1659 by 2212 pixels
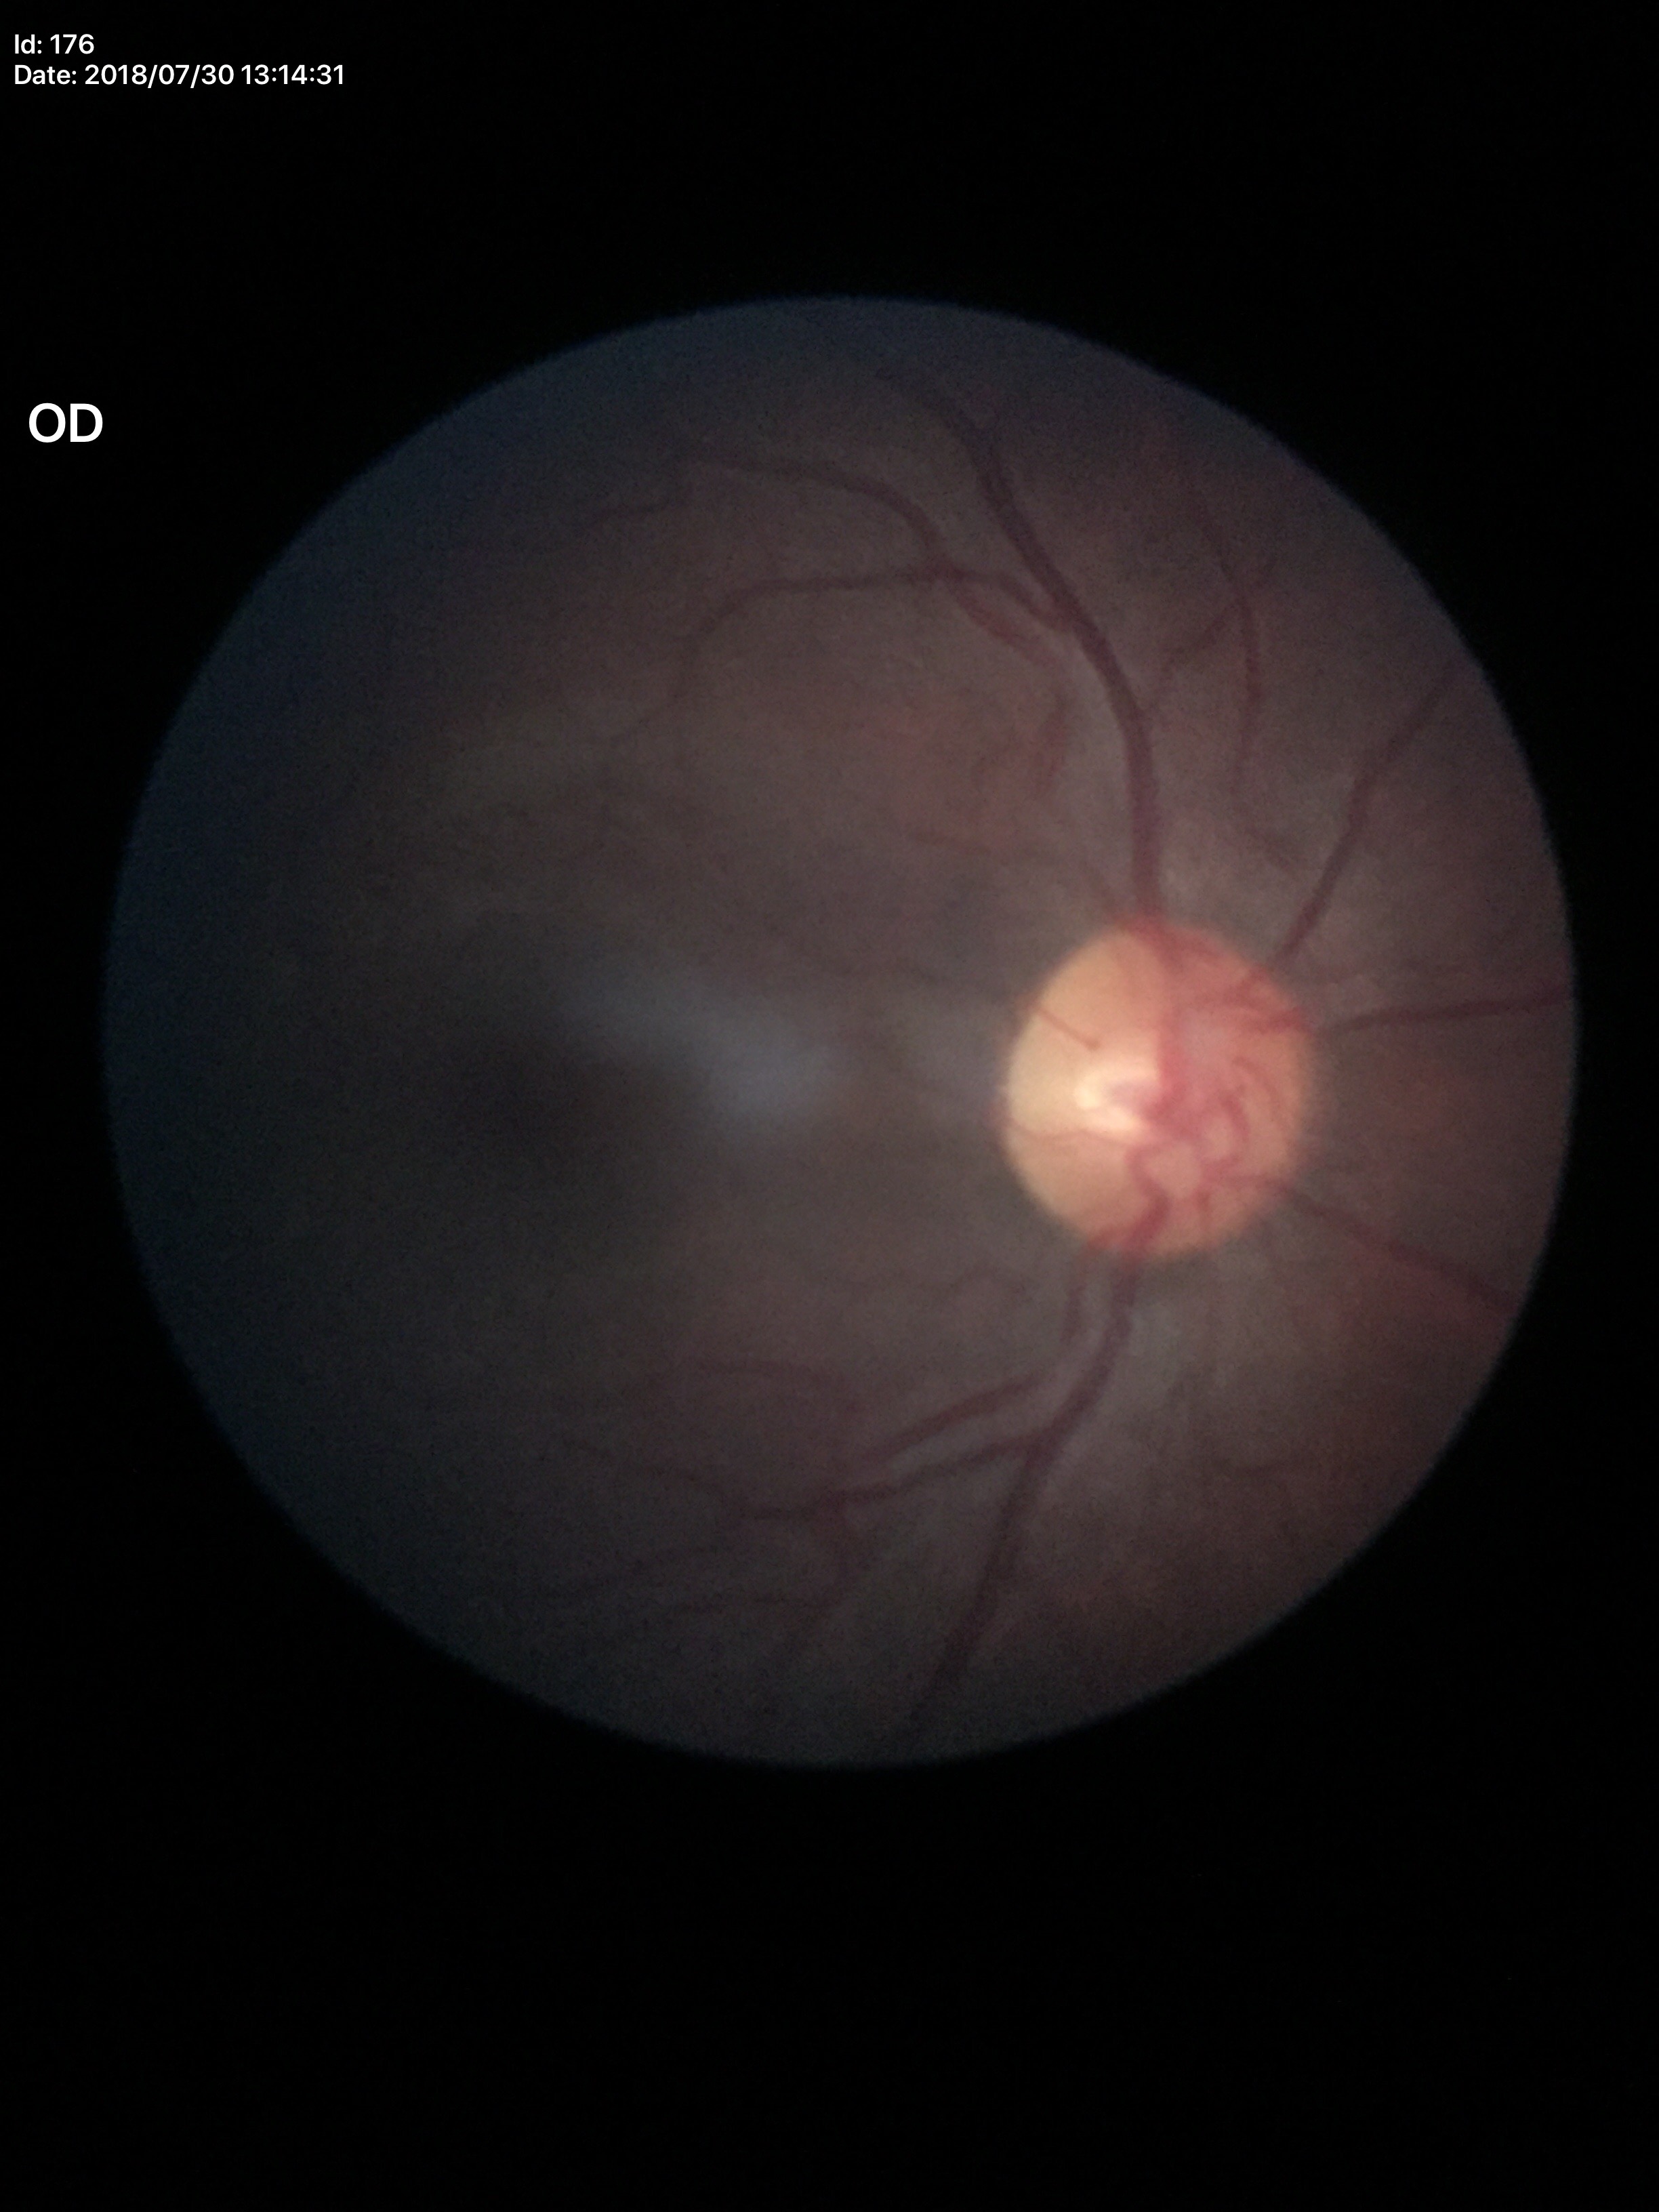 Glaucoma assessment: negative. Vertical cup-to-disc ratio: 0.43.